Phoenix ICON wide-field infant fundus image: 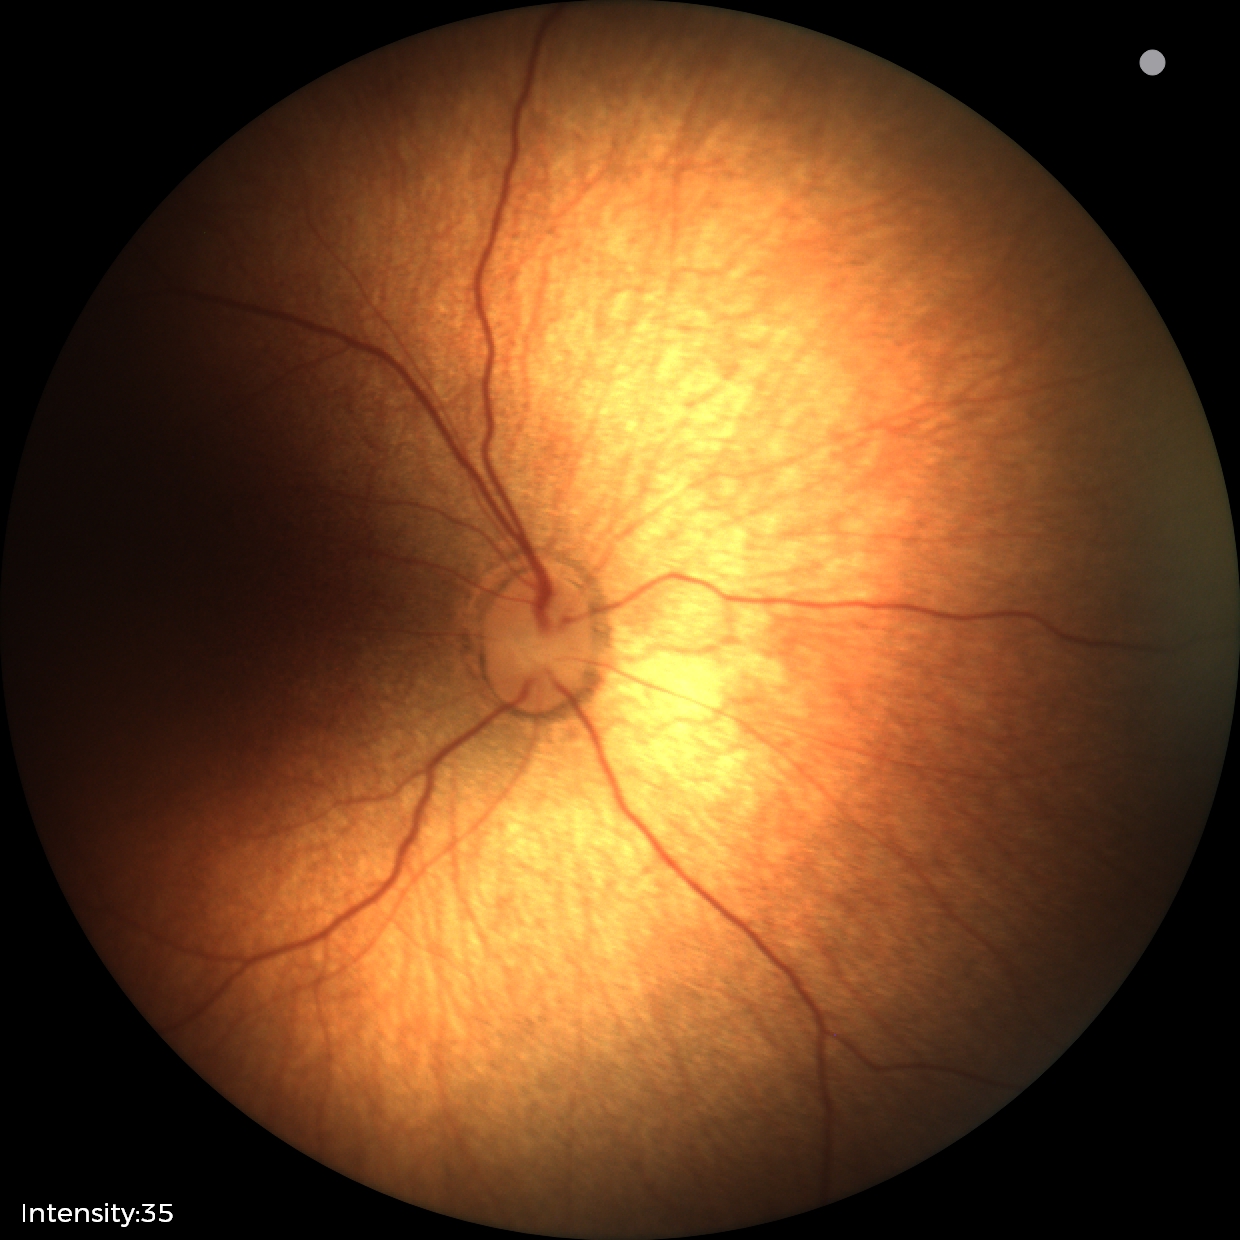 Impression: physiological appearance